Infant wide-field fundus photograph:
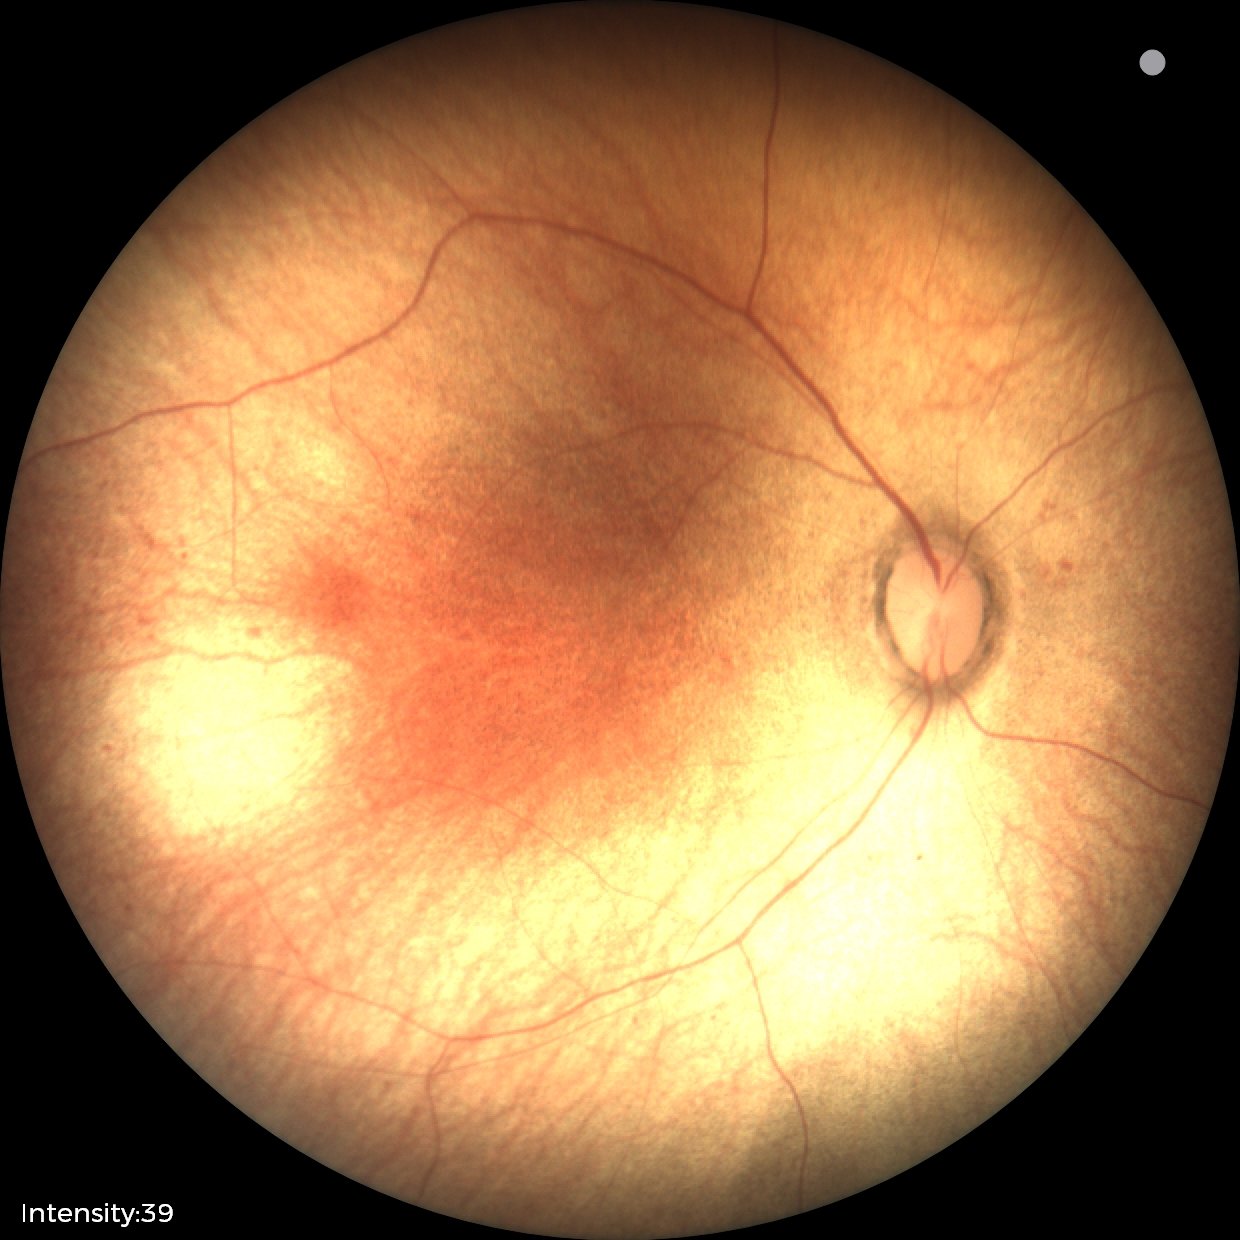

Assessment: normal retinal appearance.